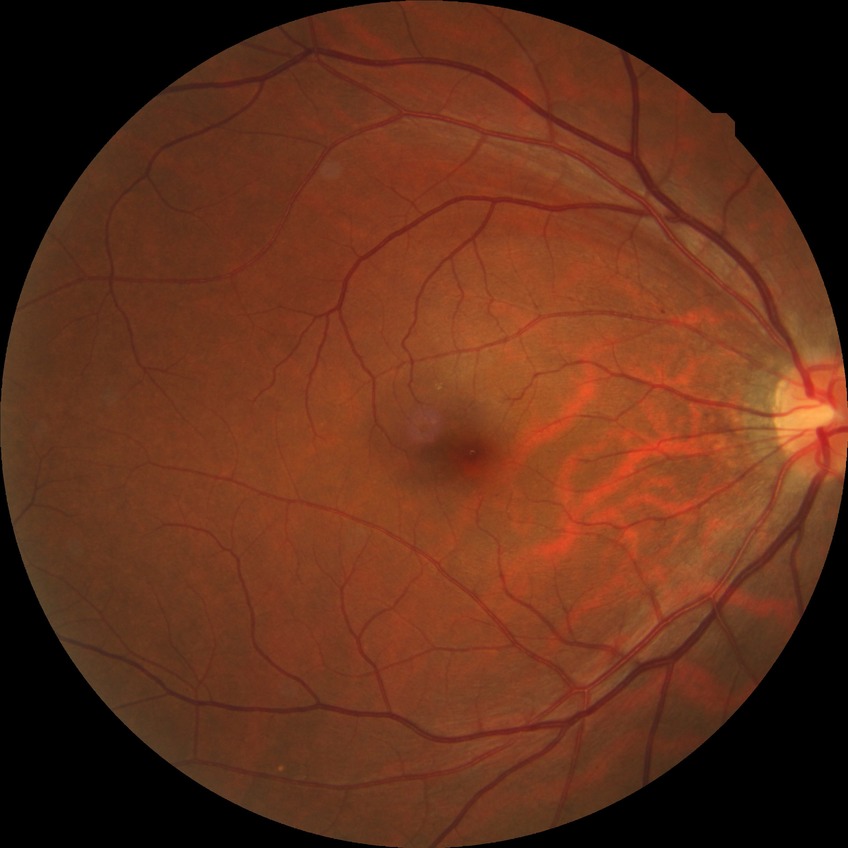 davis_grade: no diabetic retinopathy